45° field of view. Color fundus image. 848 by 848 pixels.
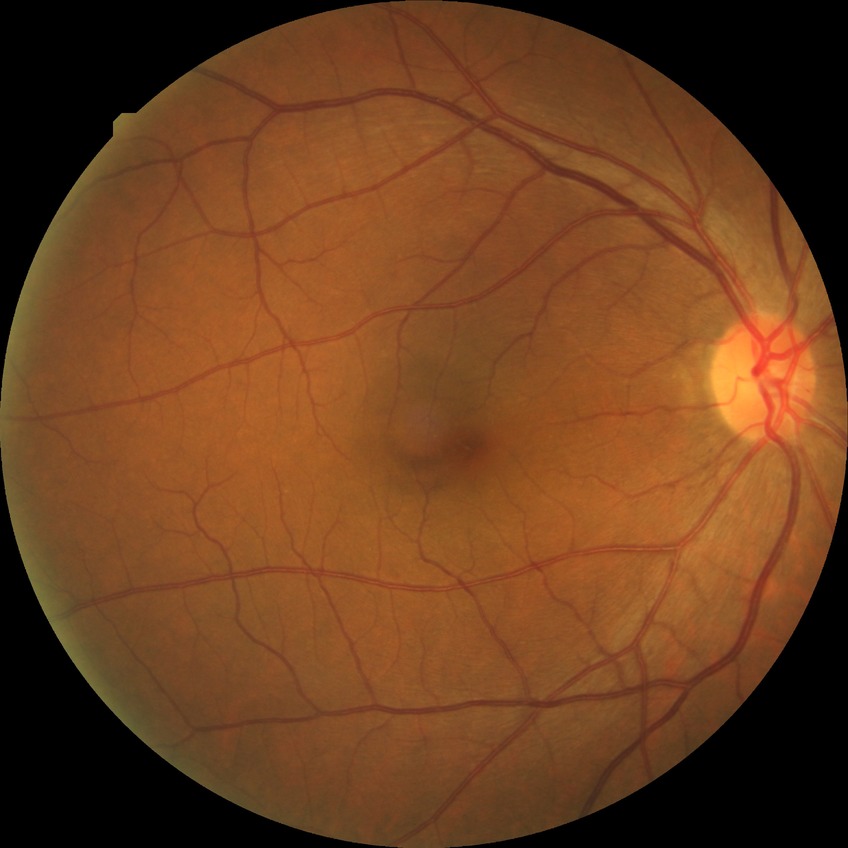
Diabetic retinopathy (DR): NDR (no diabetic retinopathy).